Captured with the Phoenix ICON (100° field of view). Infant wide-field retinal image.
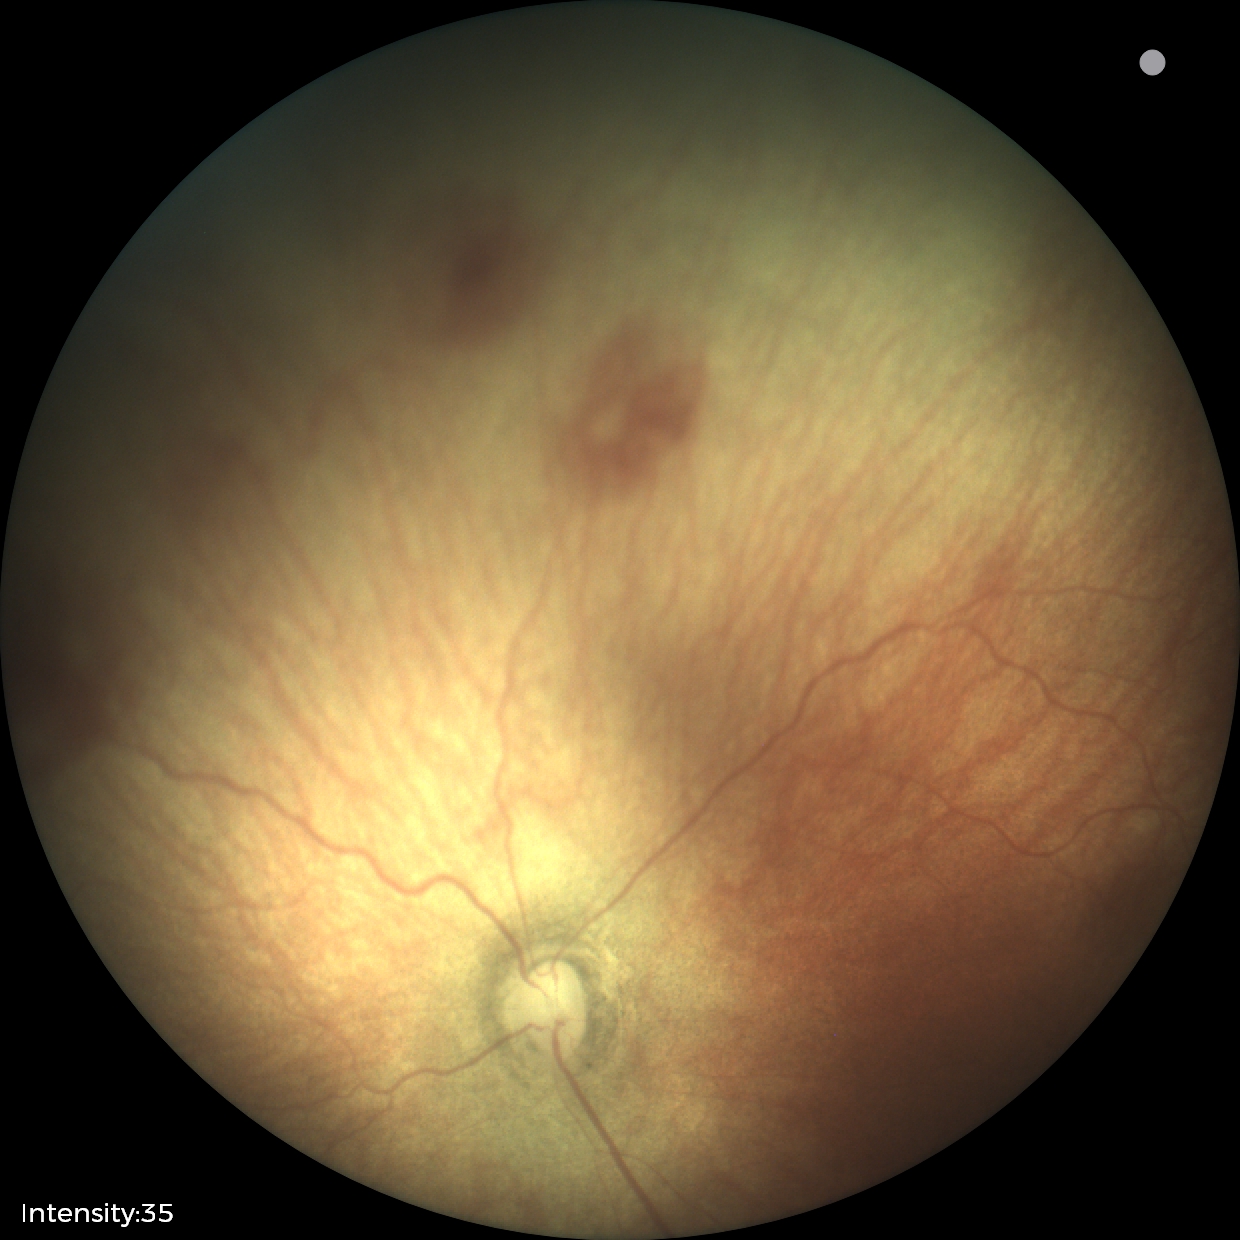 Examination diagnosed as ROP stage 0. Plus disease absent.